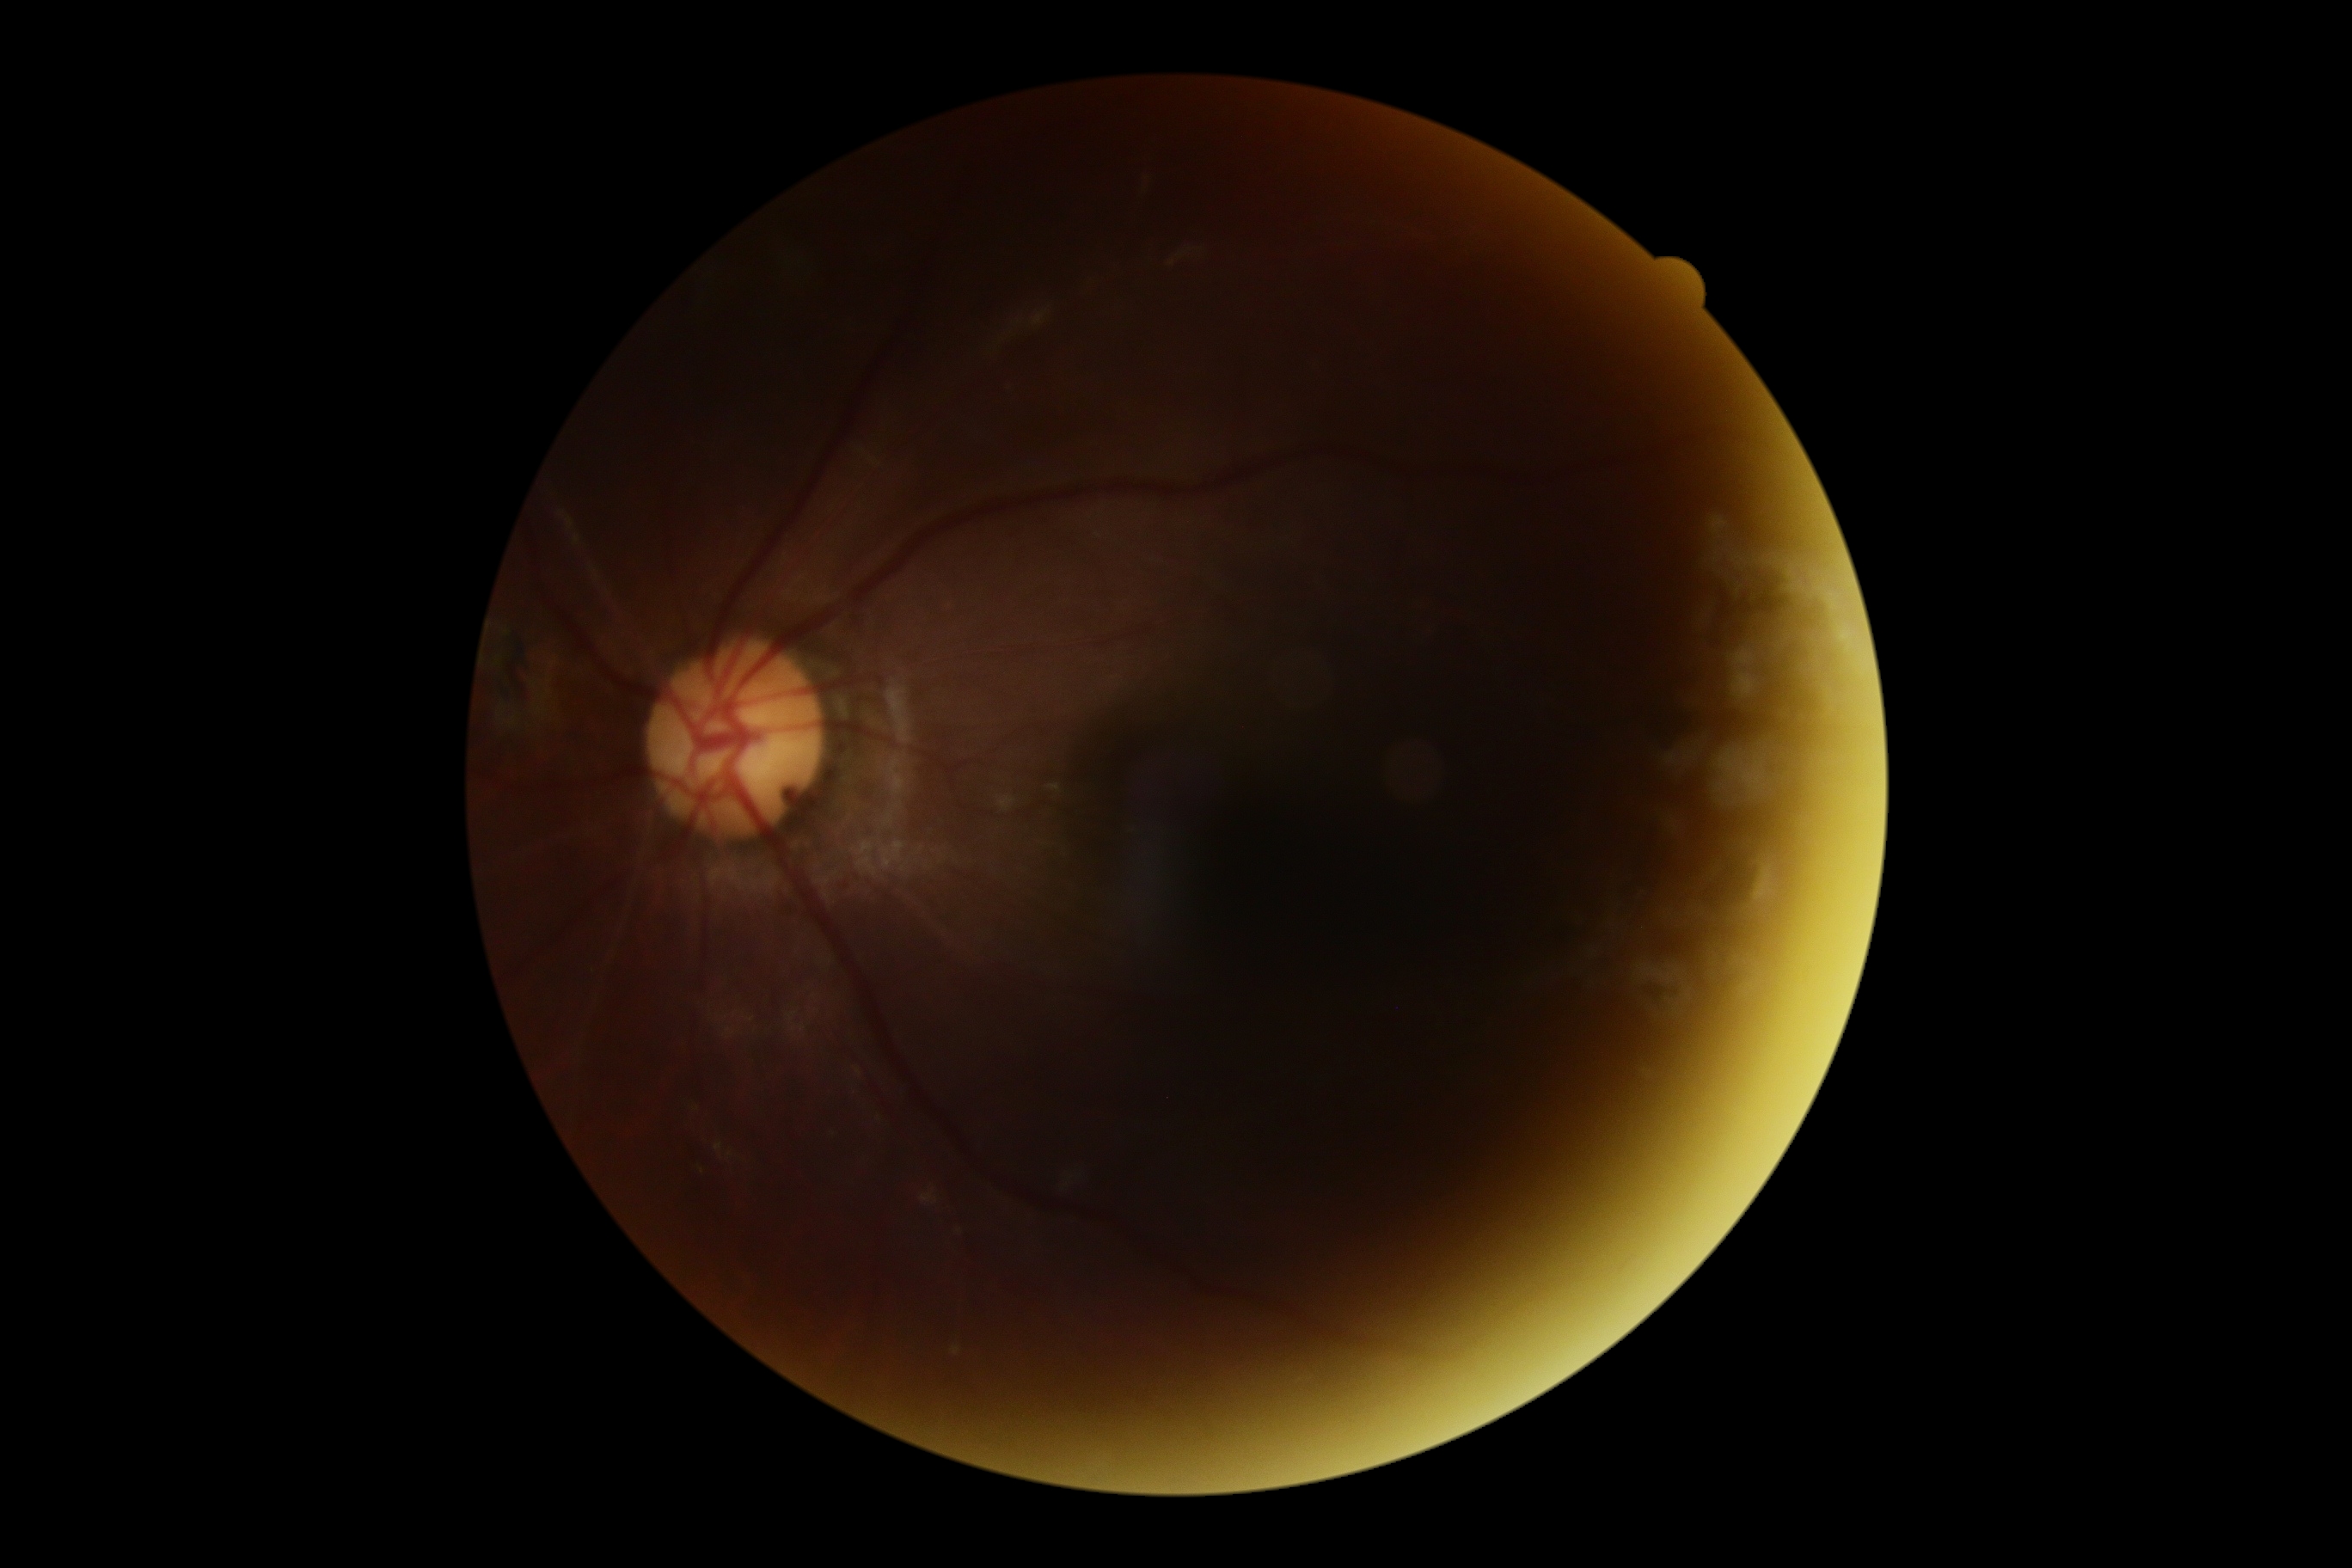 DR stage: 2/4.